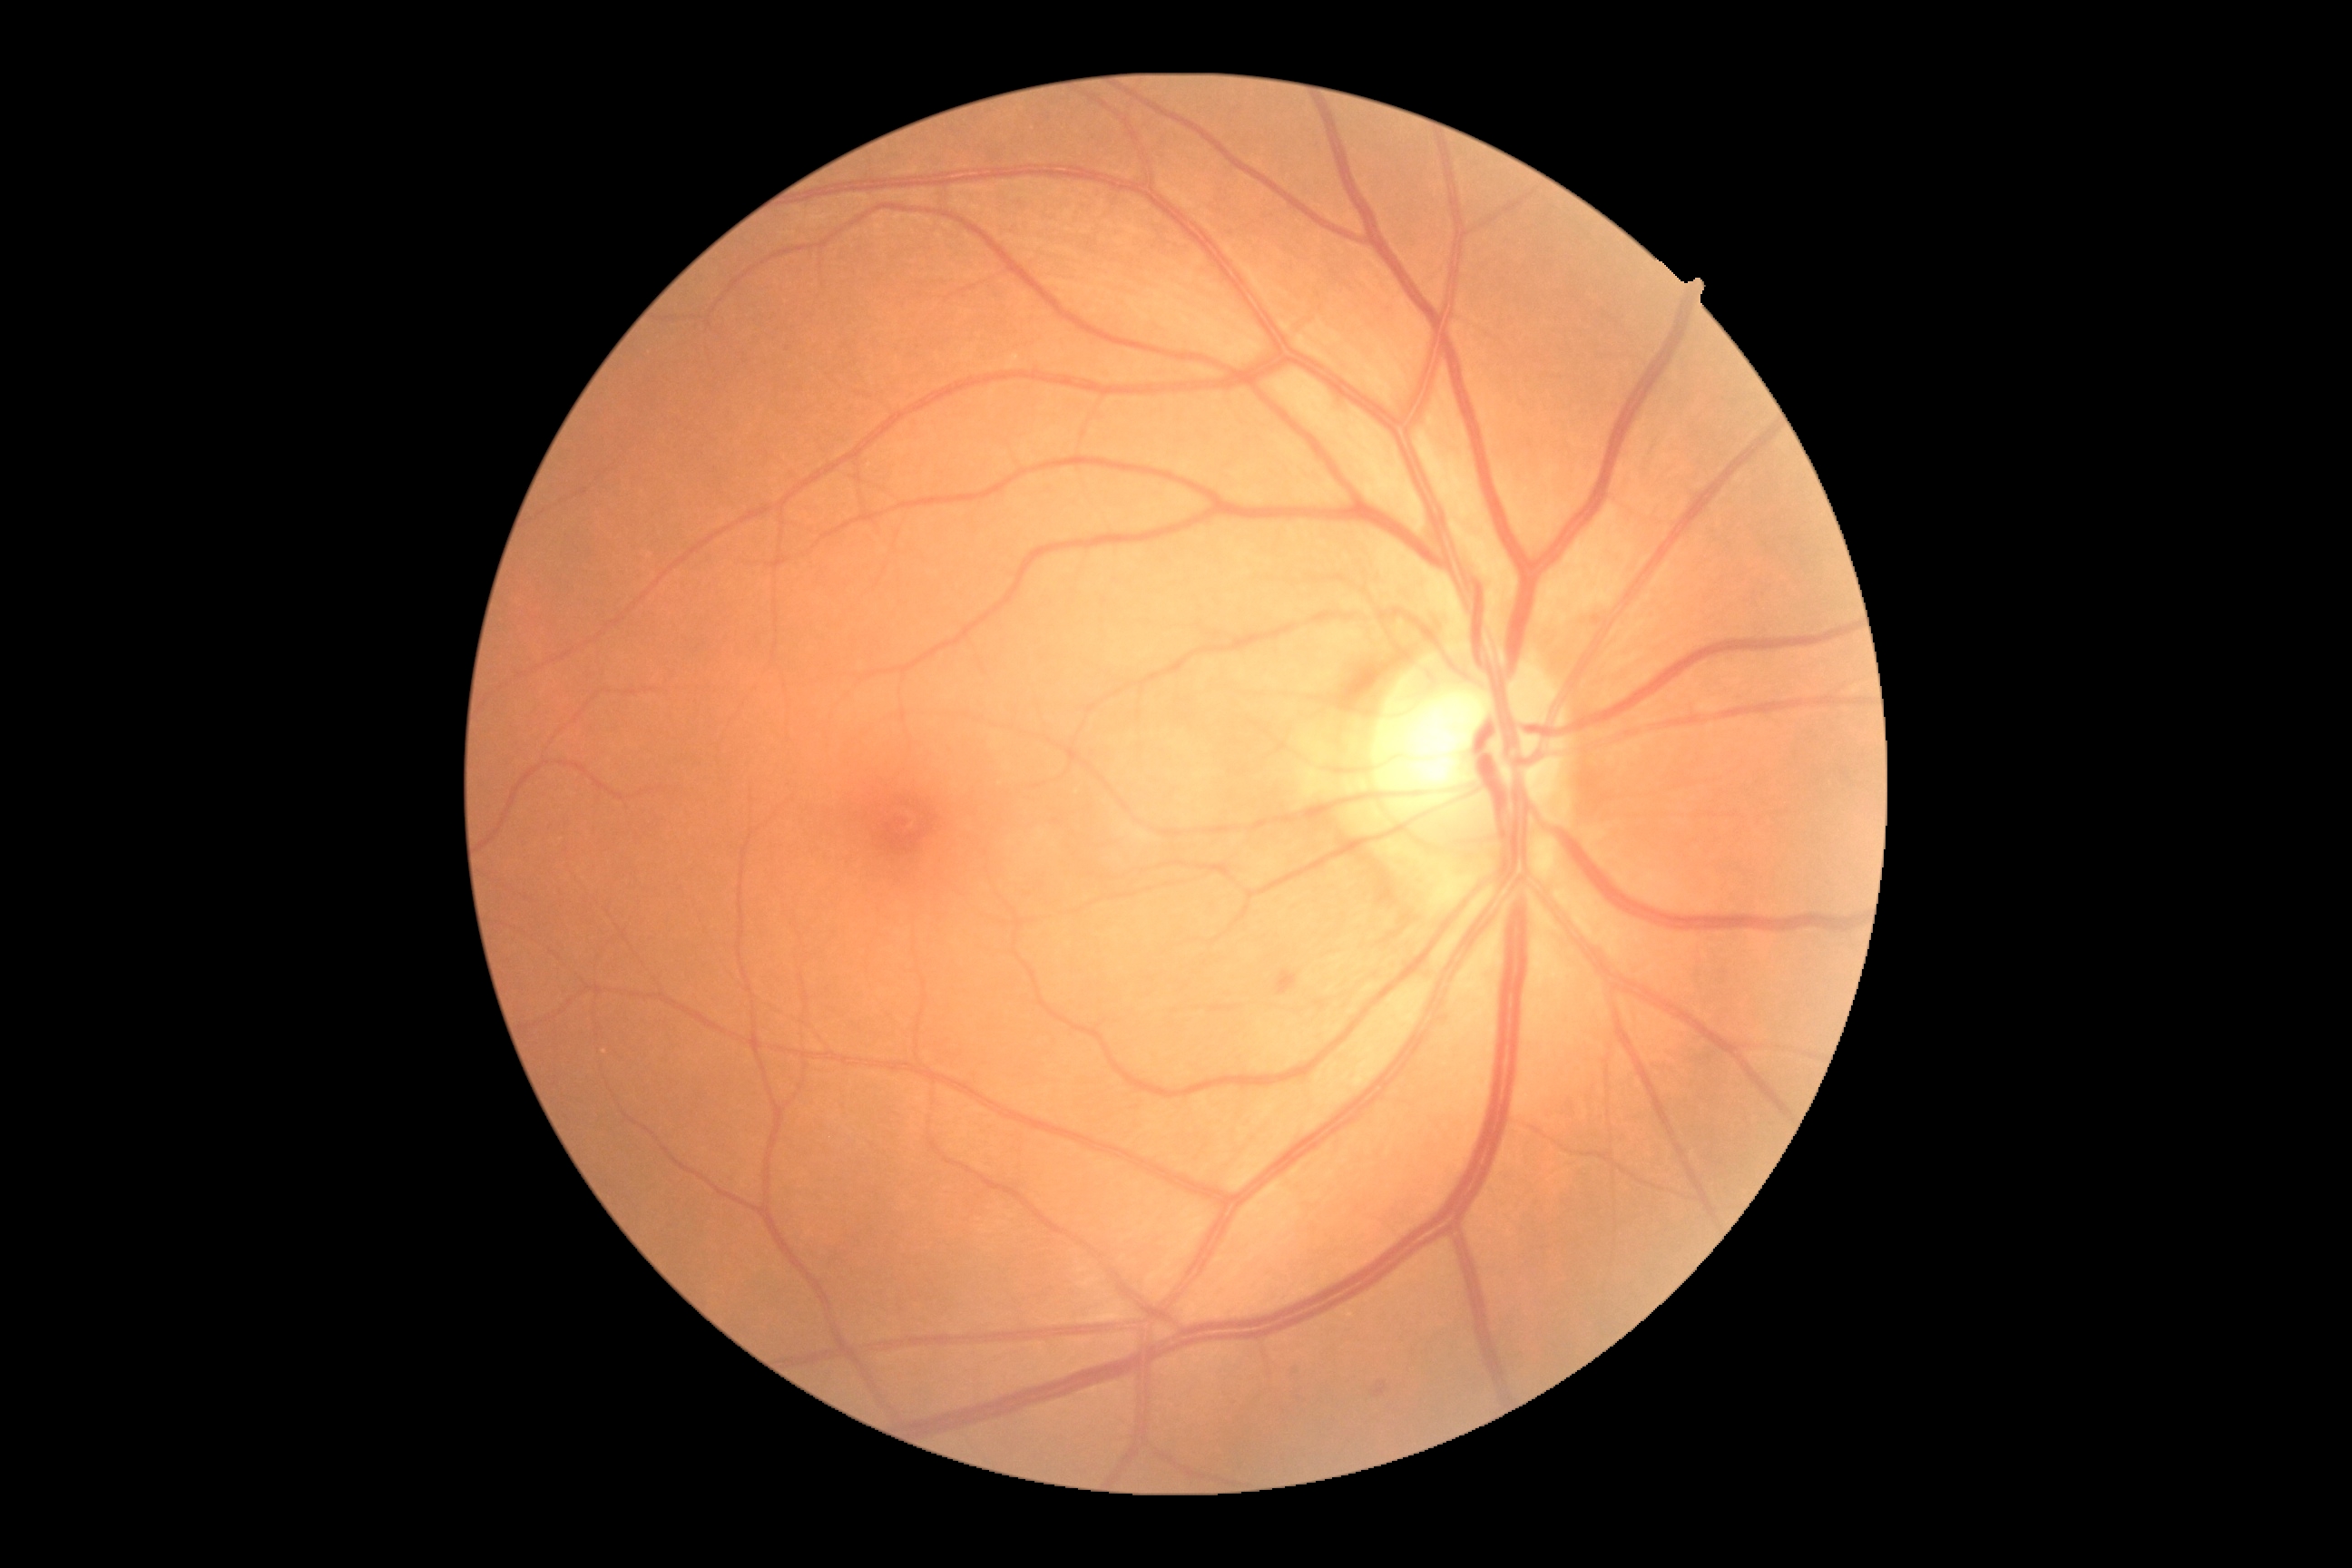
DR grade: moderate non-proliferative diabetic retinopathy (2).